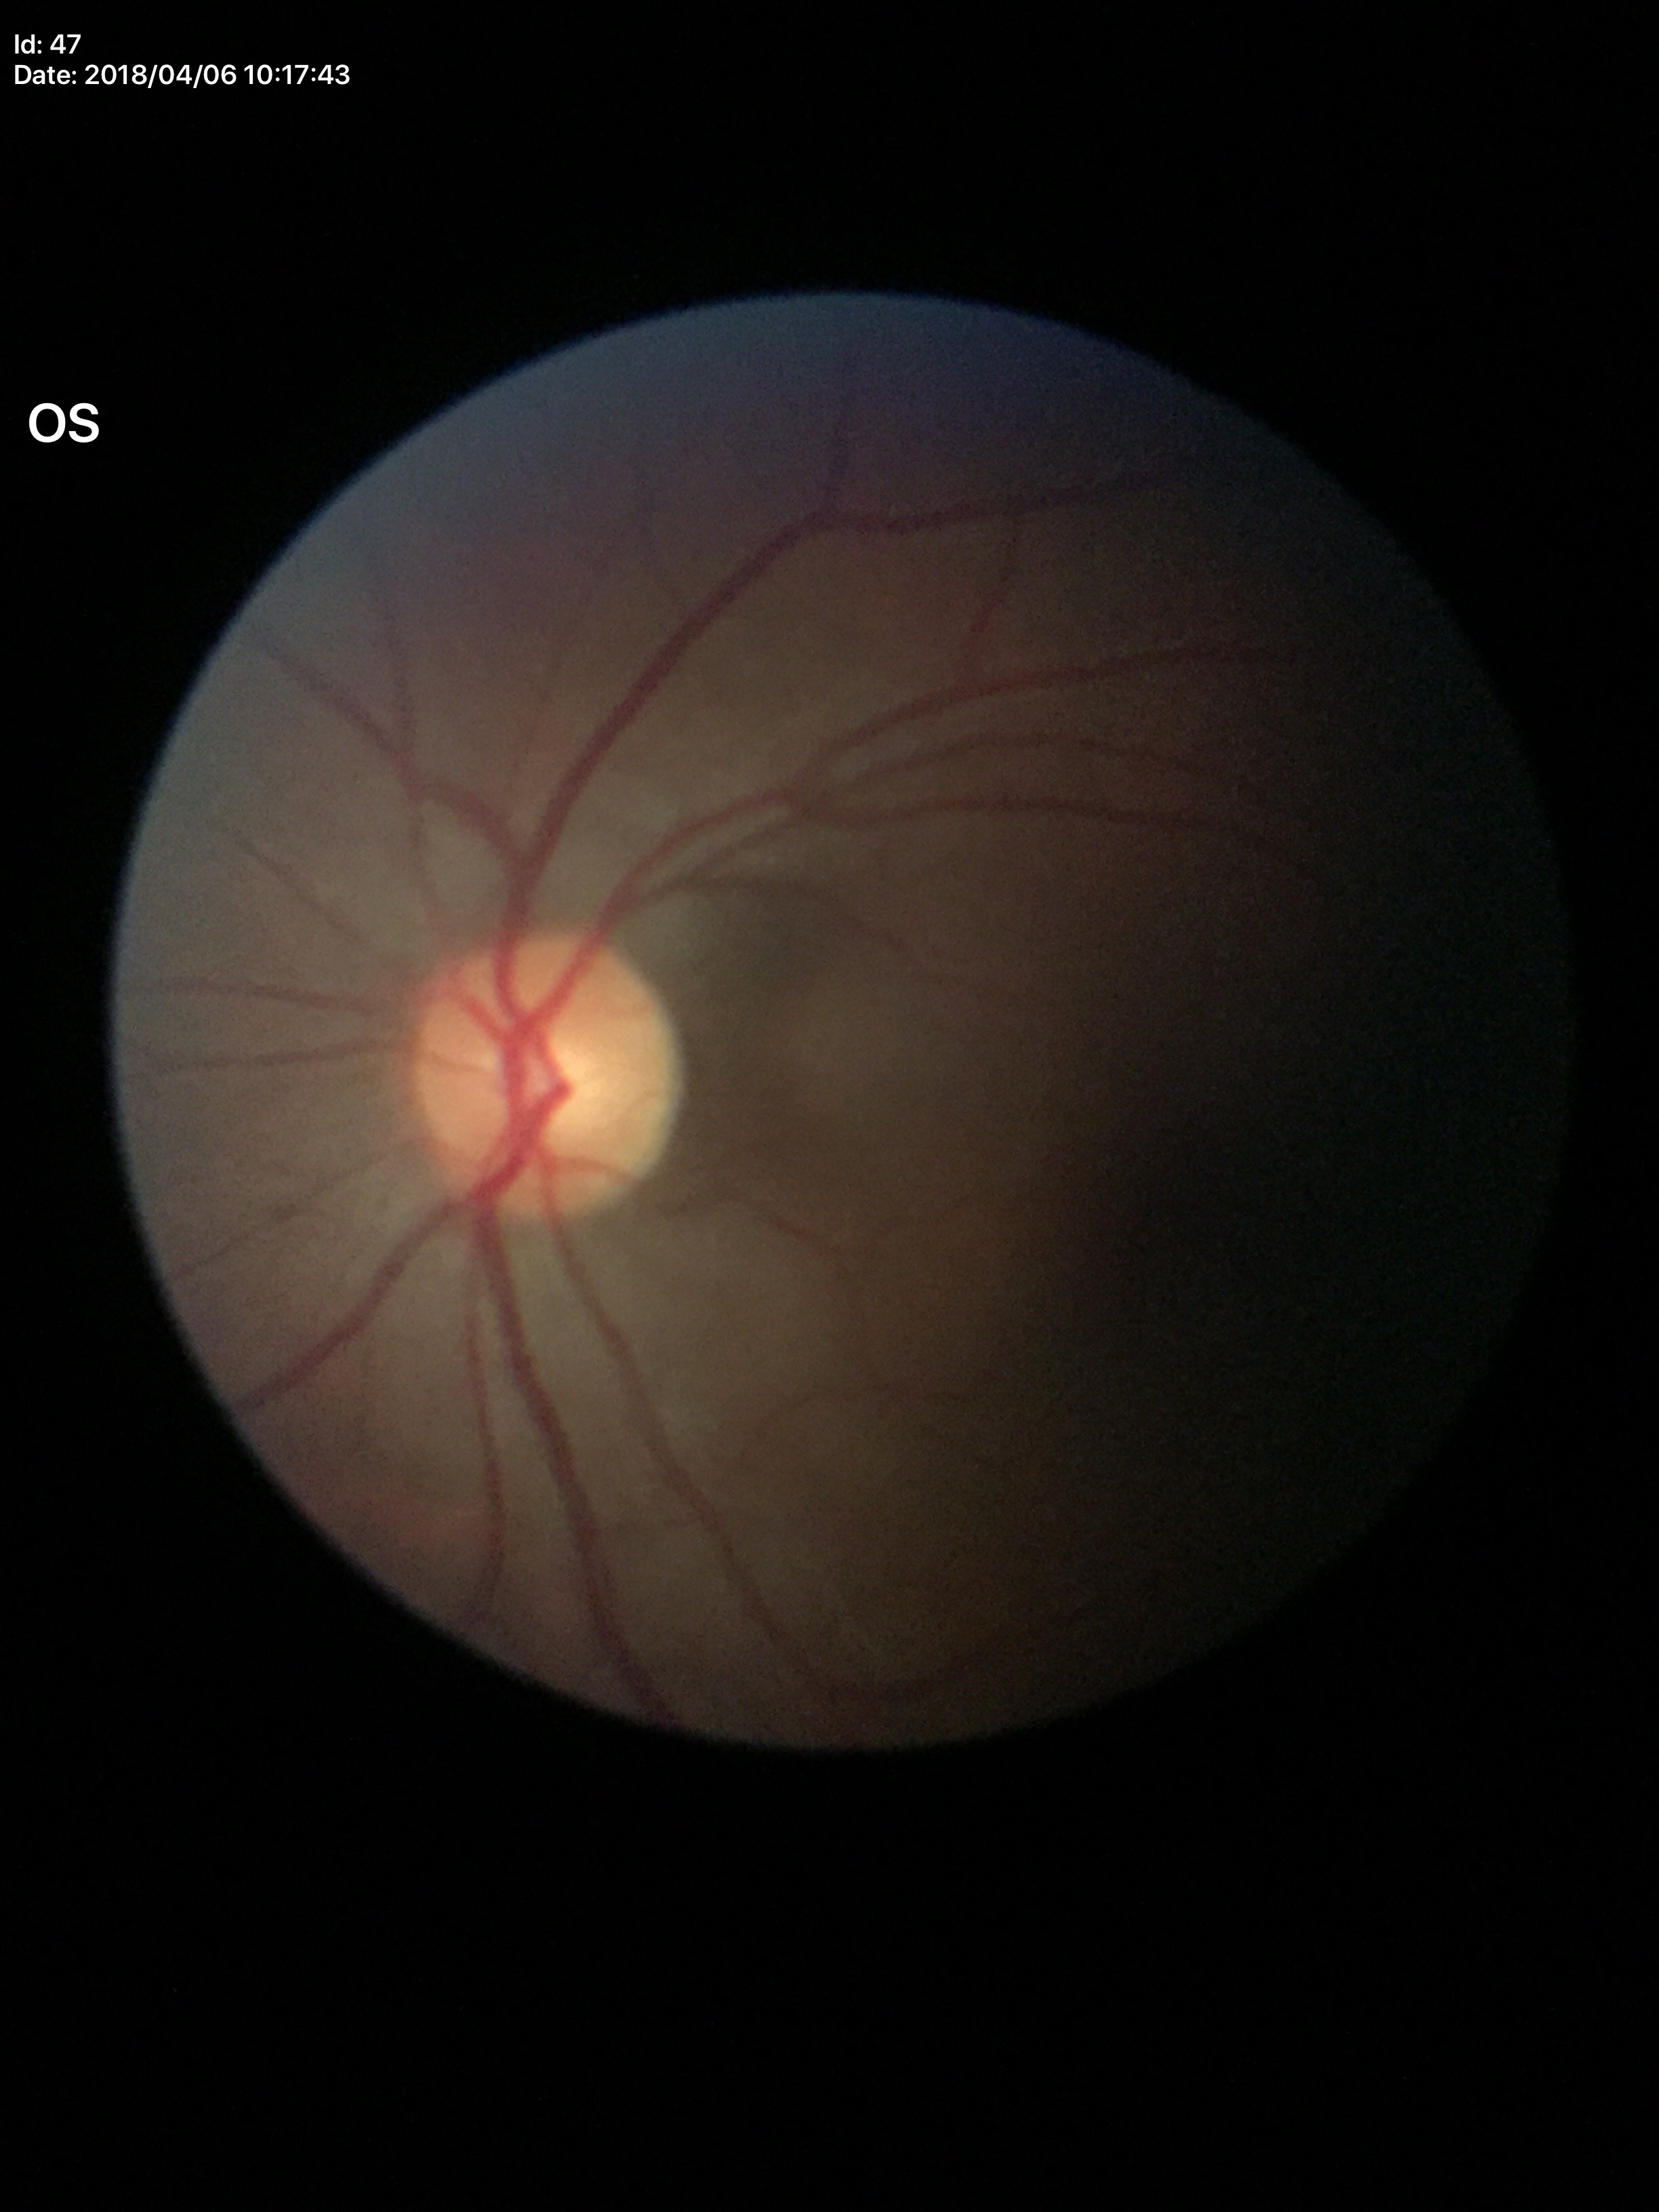 Annotations:
* VCDR: 0.50
* Glaucoma screening impression: negative